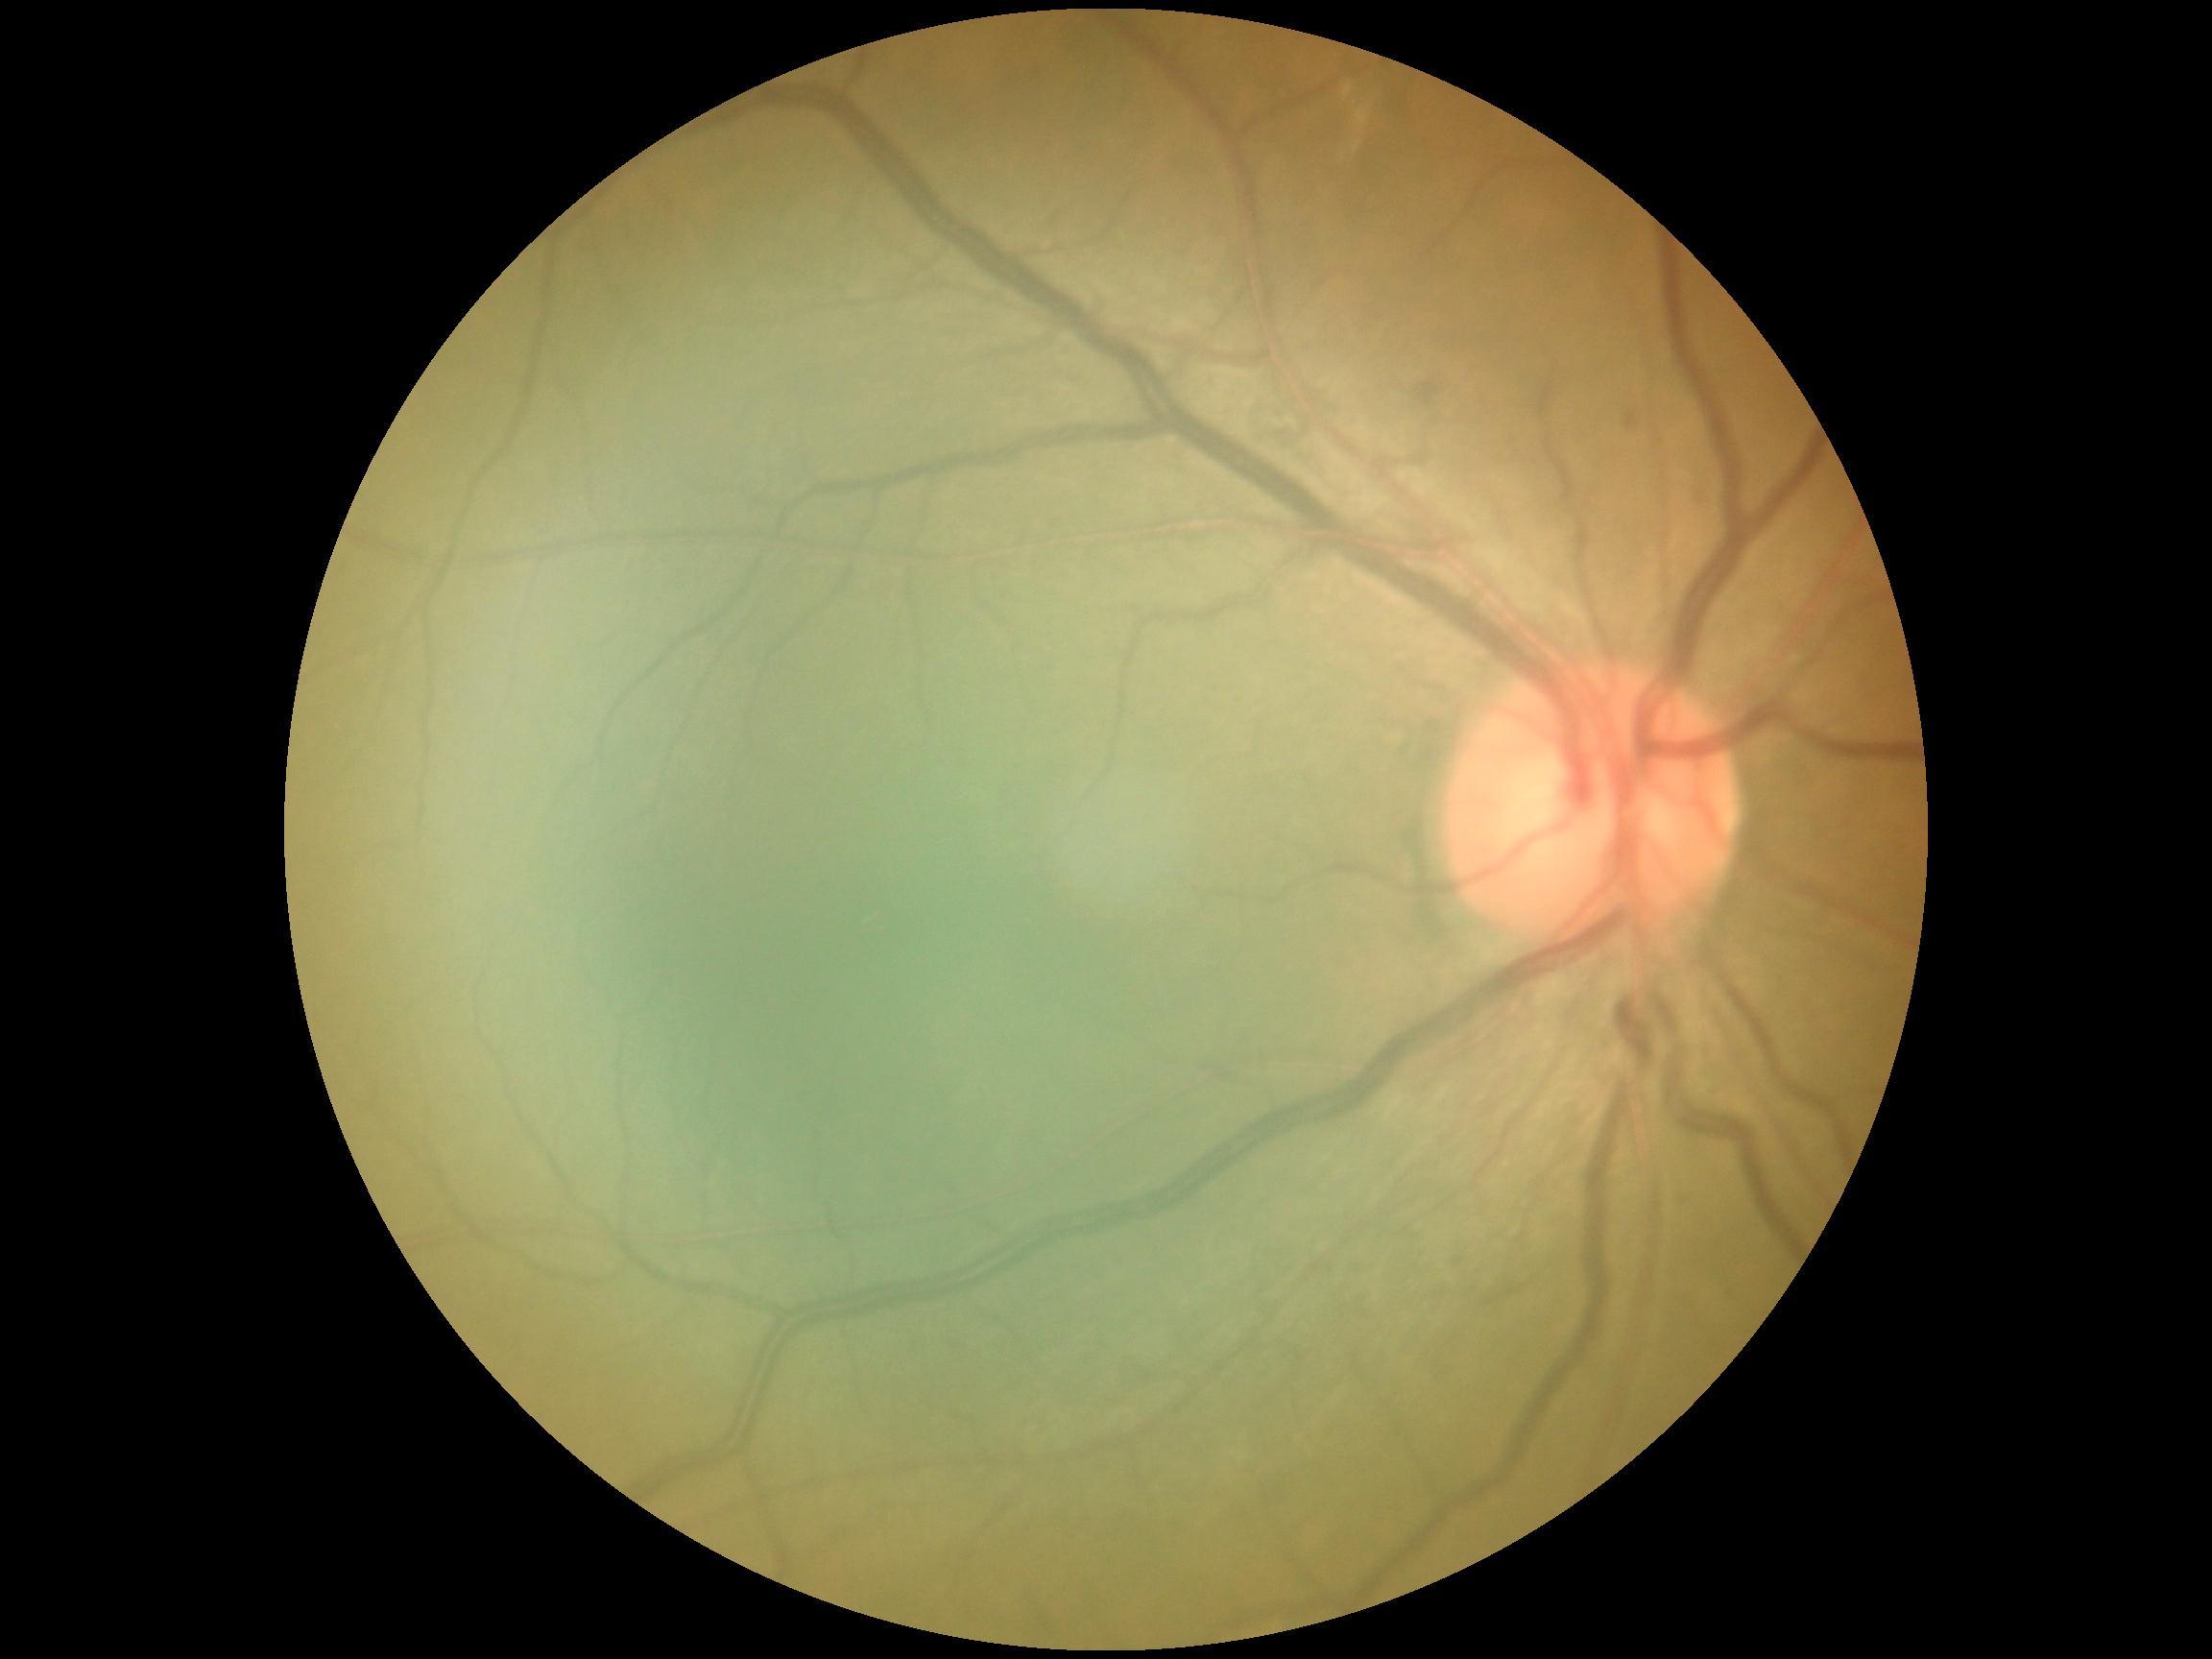
DR severity: 2.